Retinal fundus photograph, FOV: 45 degrees, 1932x1916 — 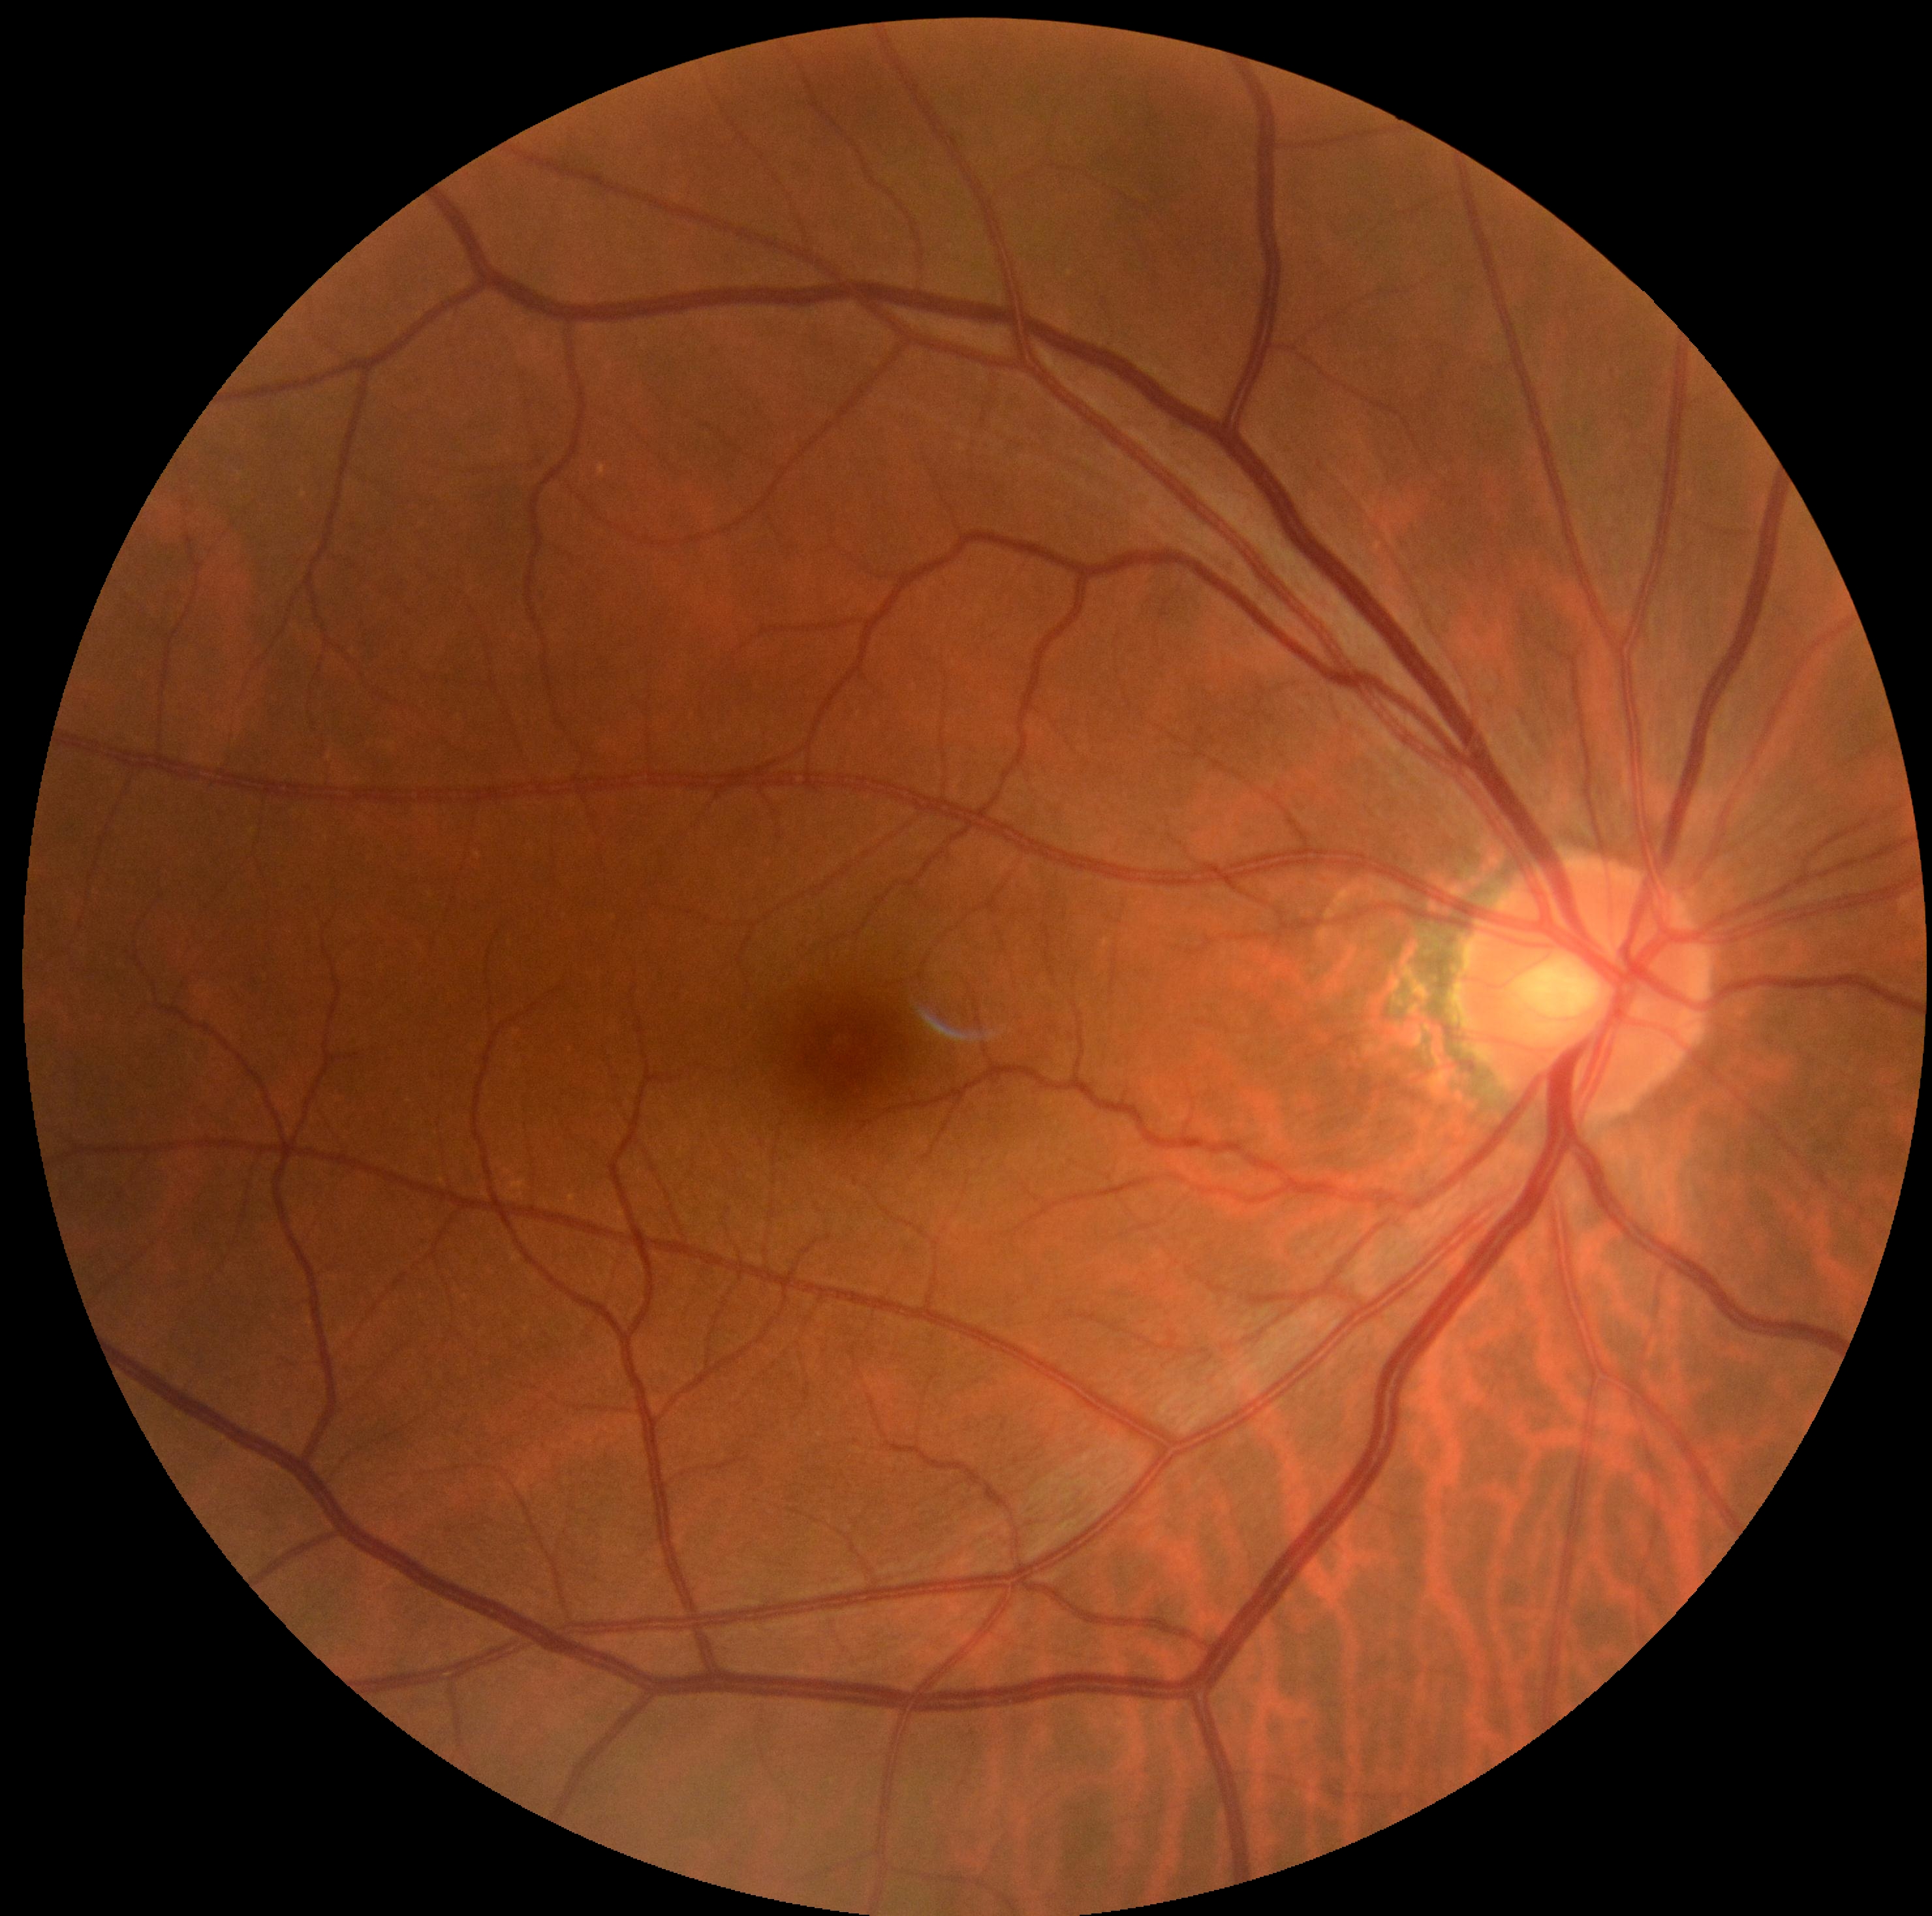

{"dr_grade": "no apparent diabetic retinopathy (grade 0)", "dr_impression": "no DR findings"}